45° FOV · fundus photo · 2352 by 1568 pixels.
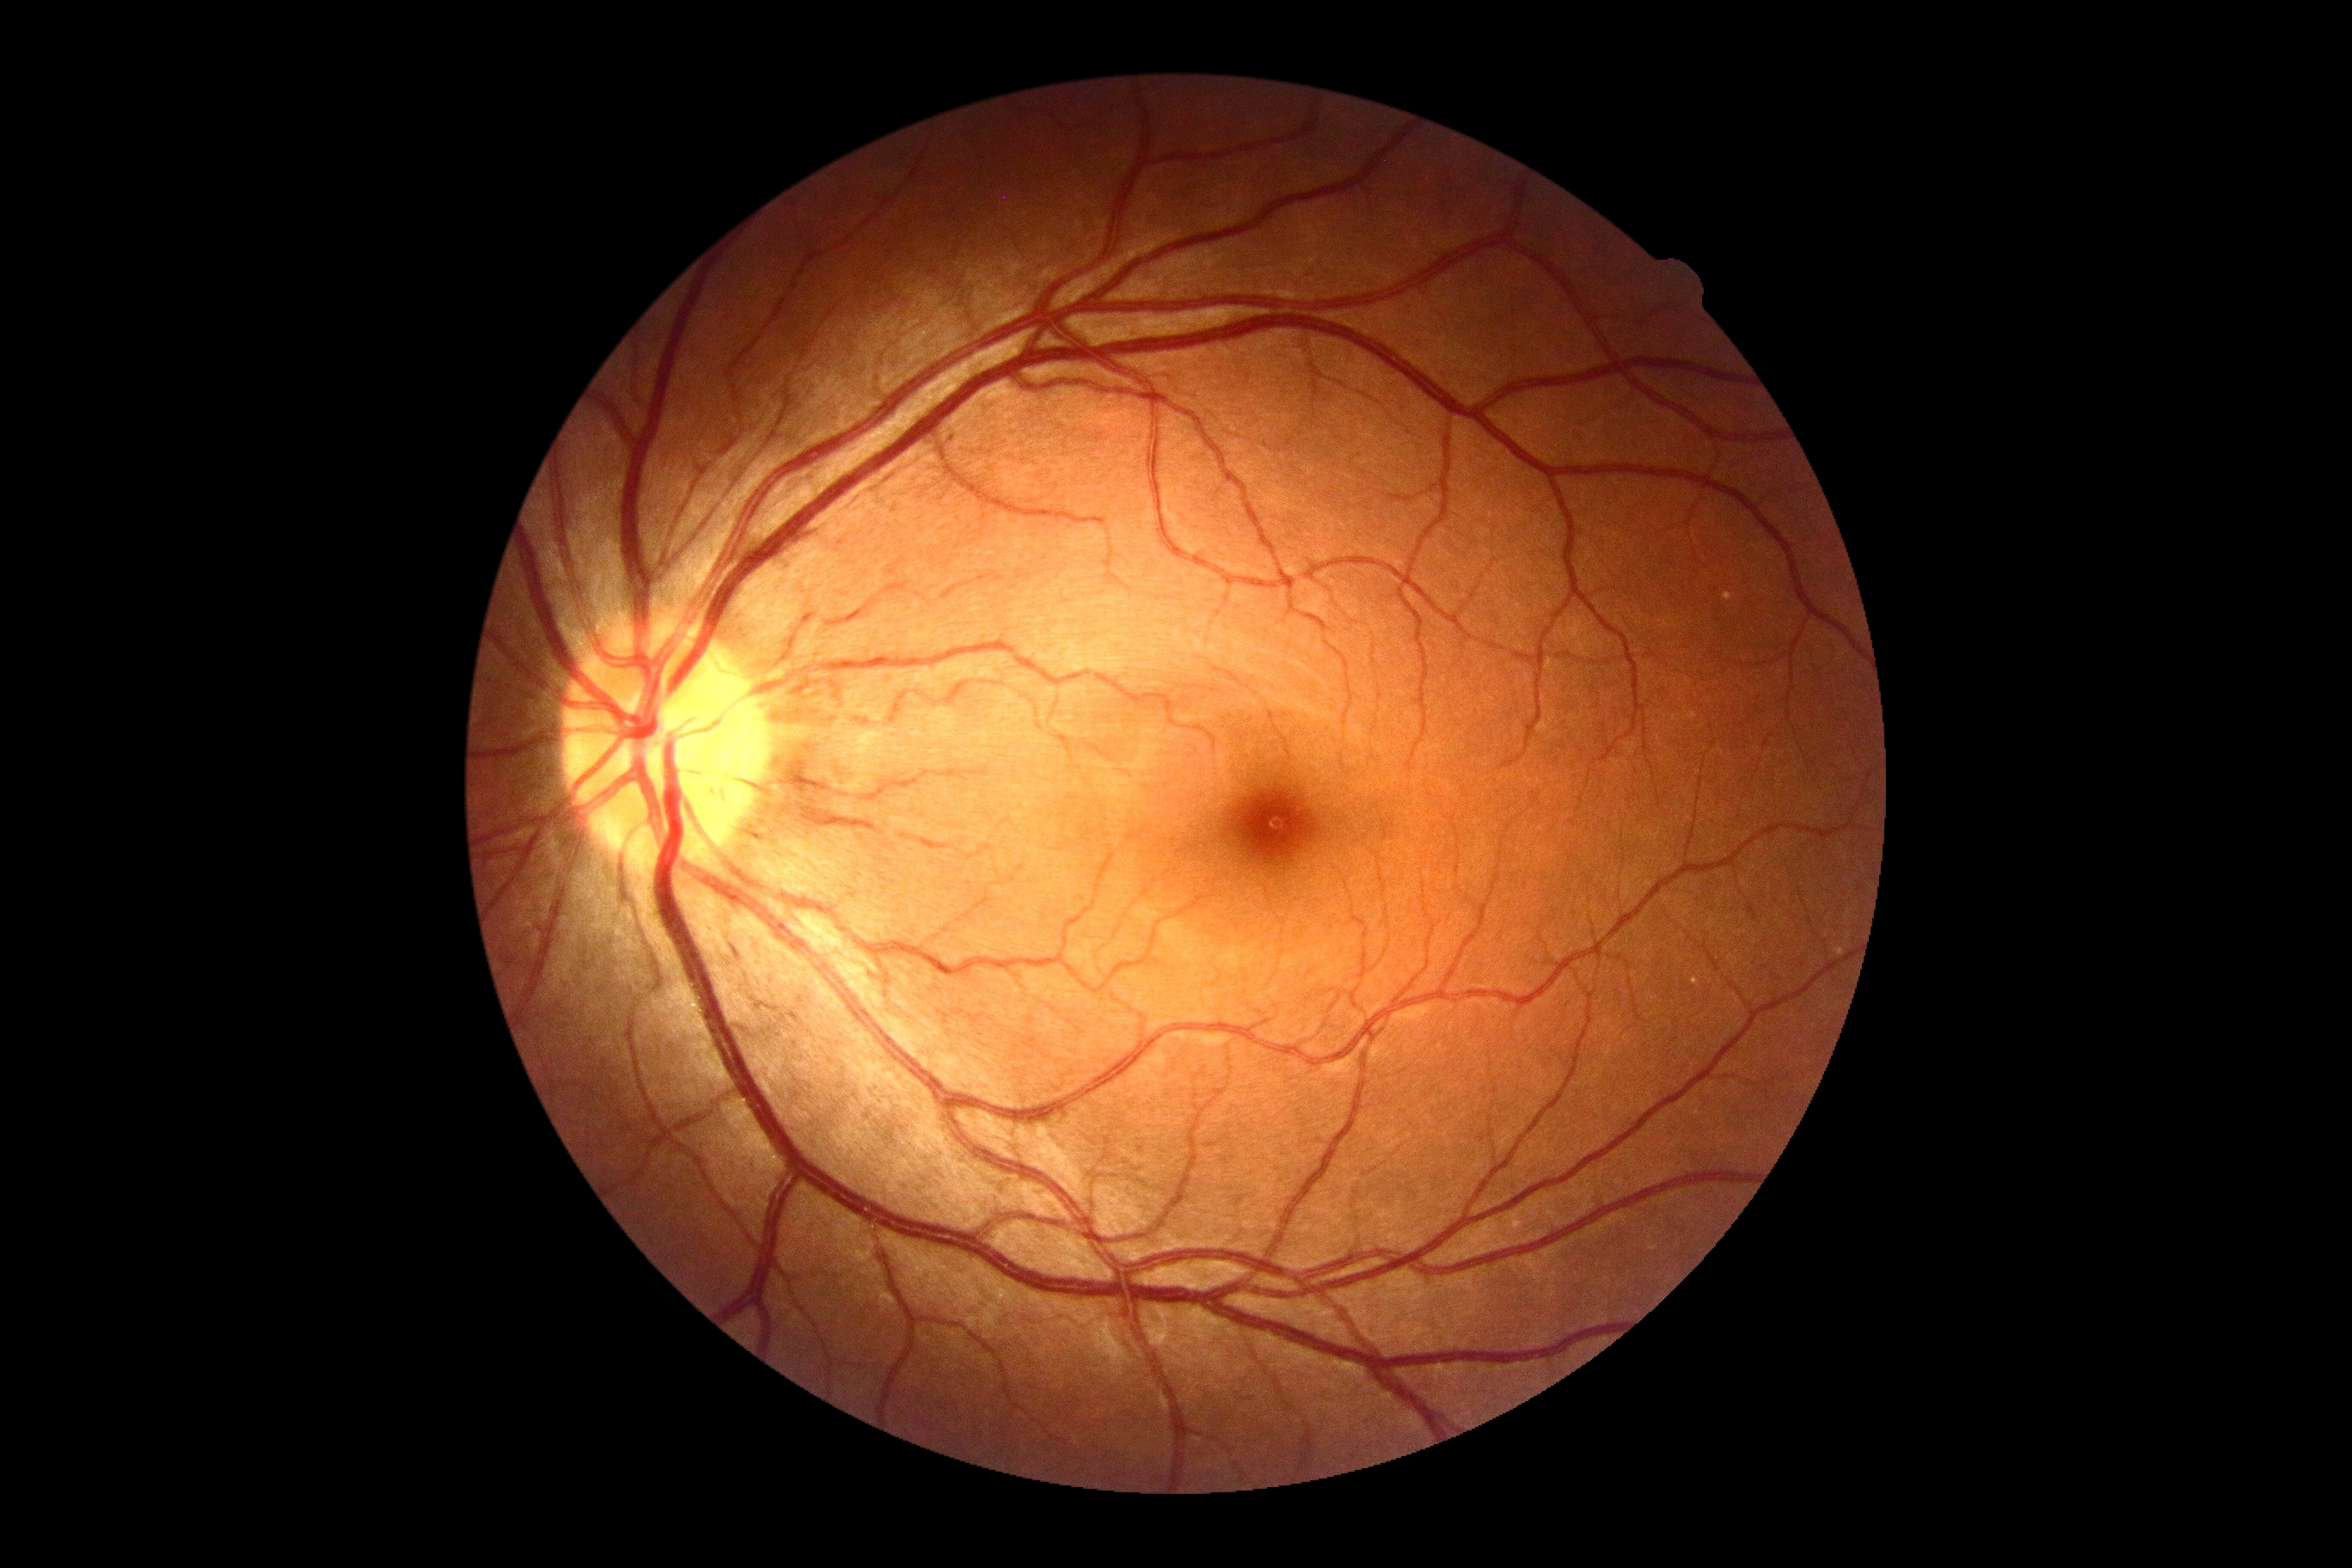

{"dr_impression": "negative for DR", "dr_grade": "0"}